Fundus photo. Image size 2352x1568. 45-degree field of view.
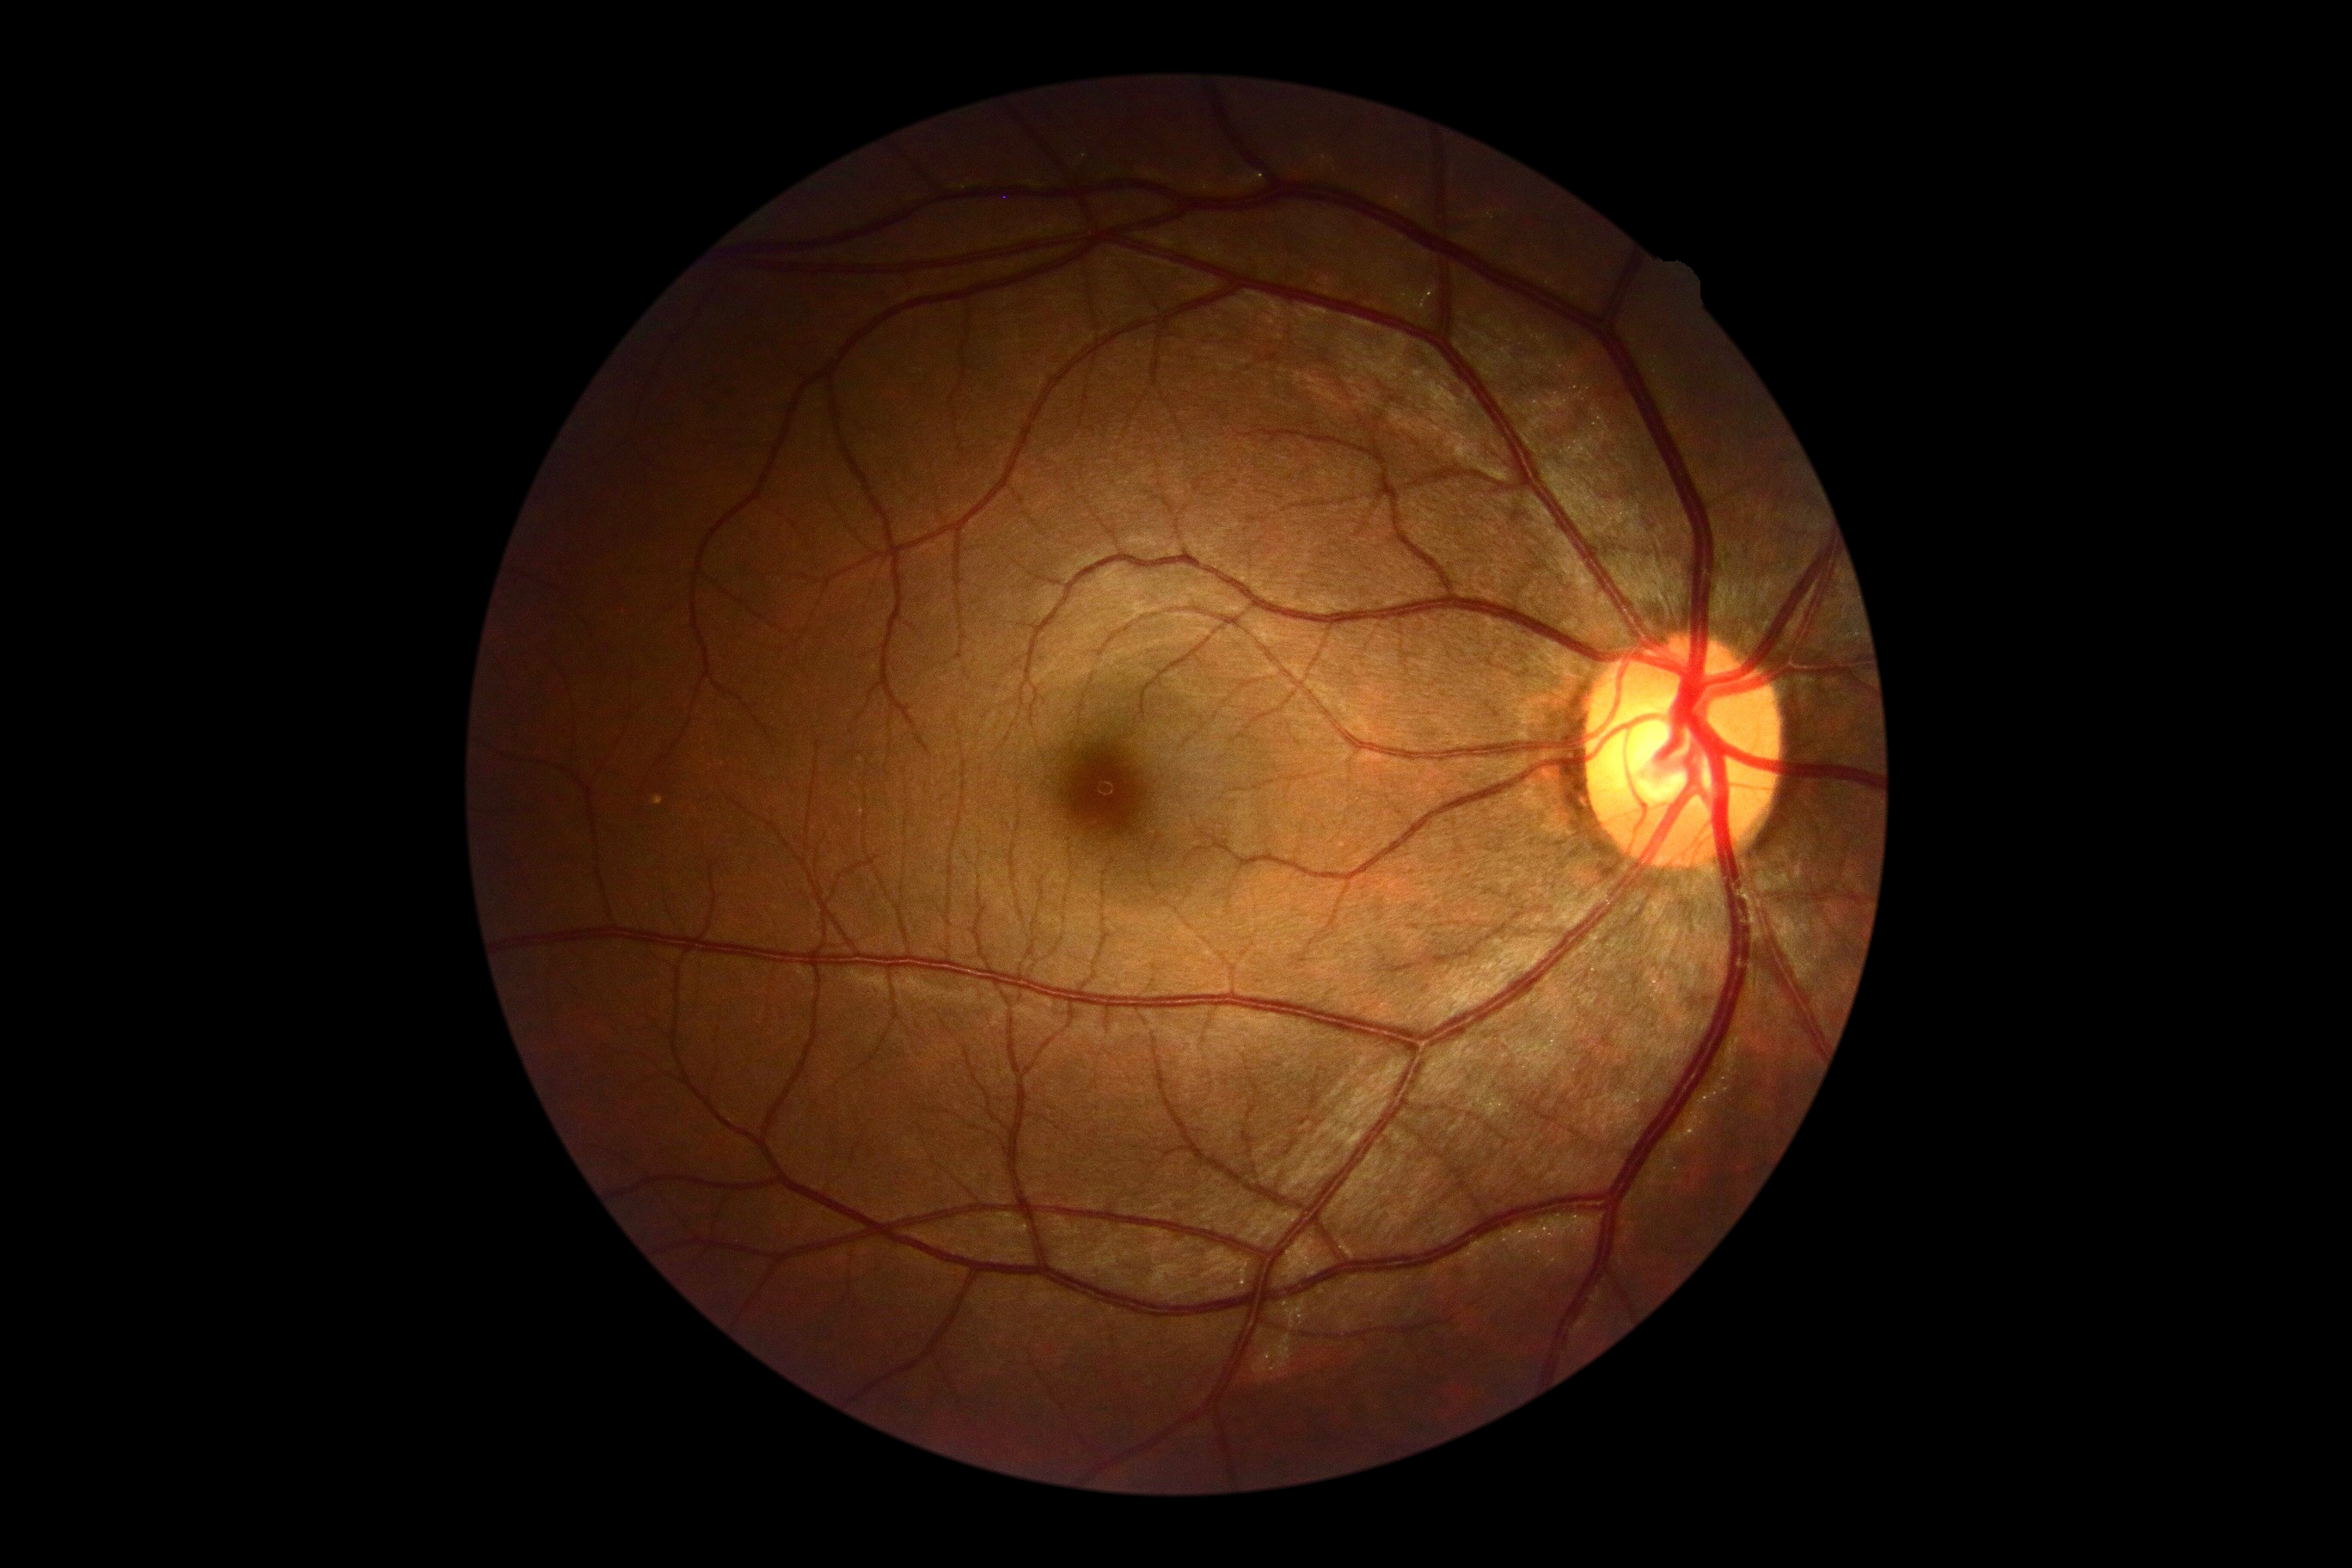 DR severity: no apparent diabetic retinopathy (grade 0).